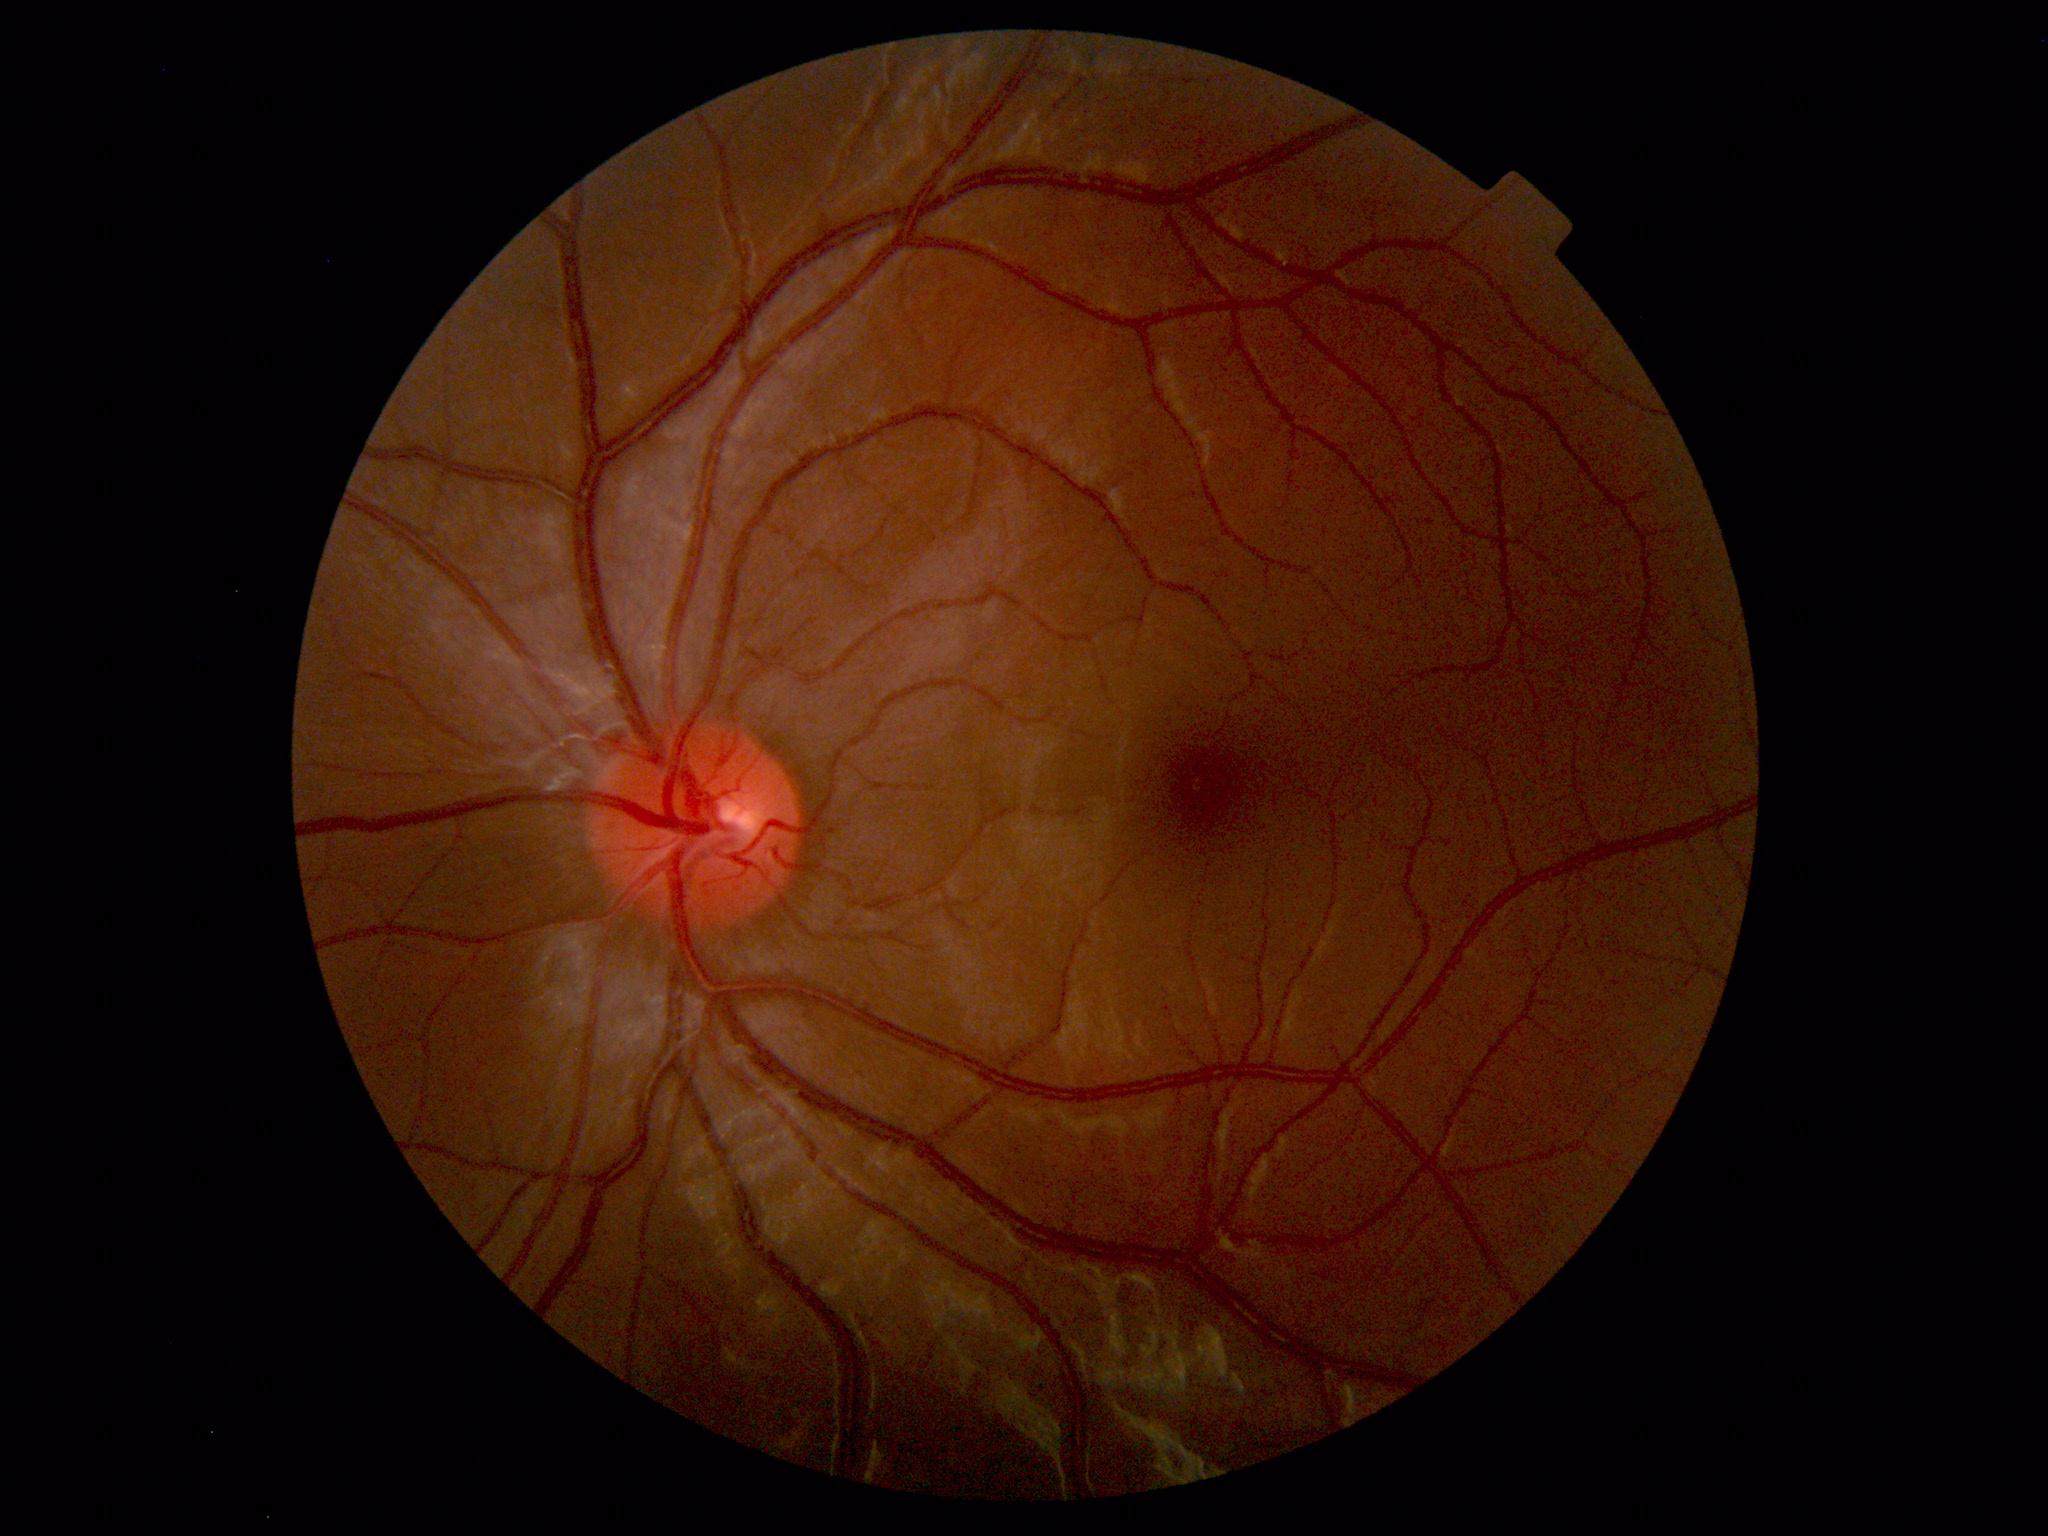
Findings: none. Normal fundus.